Infant wide-field fundus photograph. 640x480:
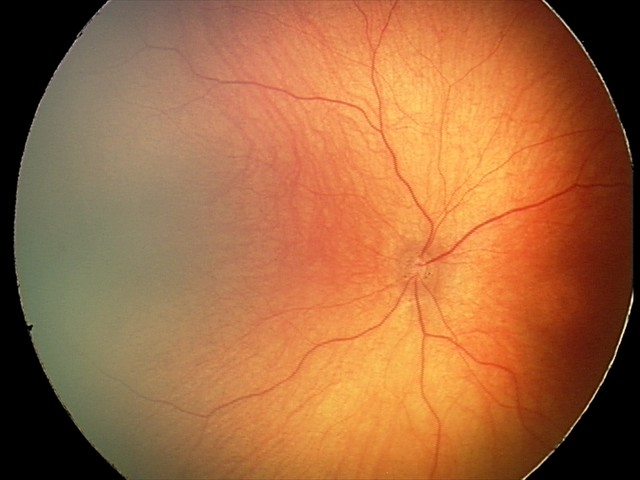
Finding: normal retinal appearance